Color fundus image:
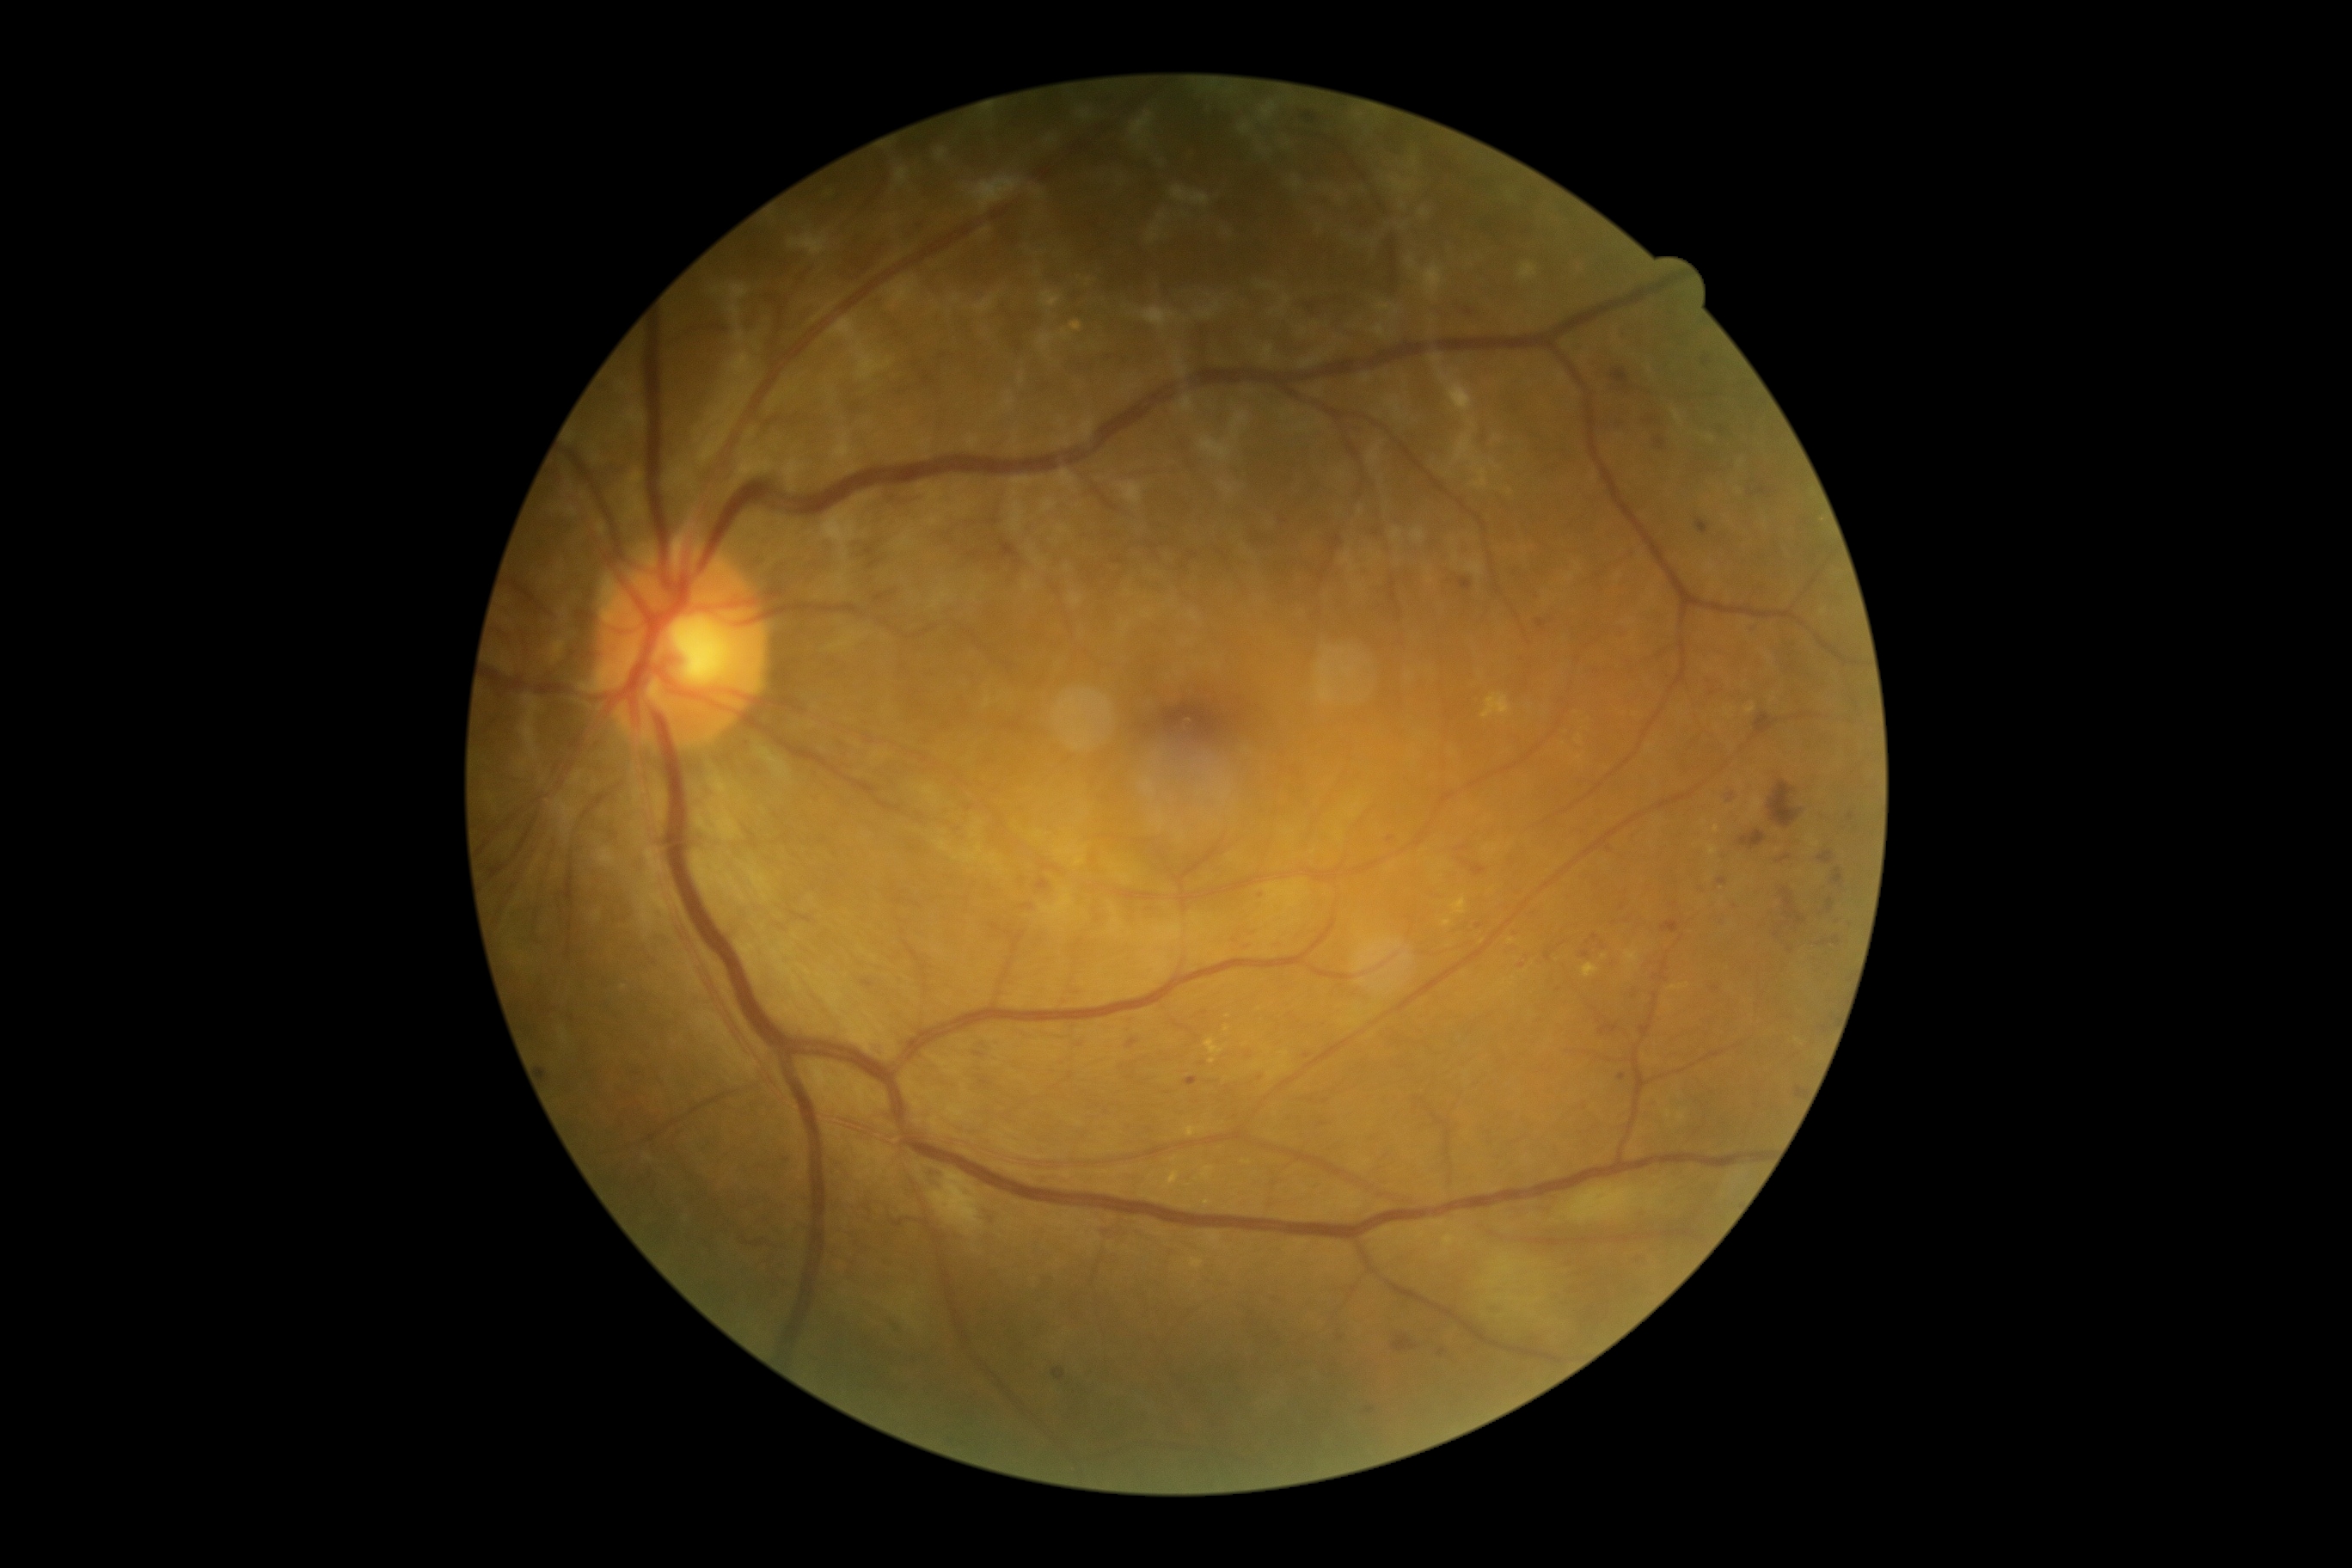
DR stage = 2.